Infant wide-field fundus photograph — 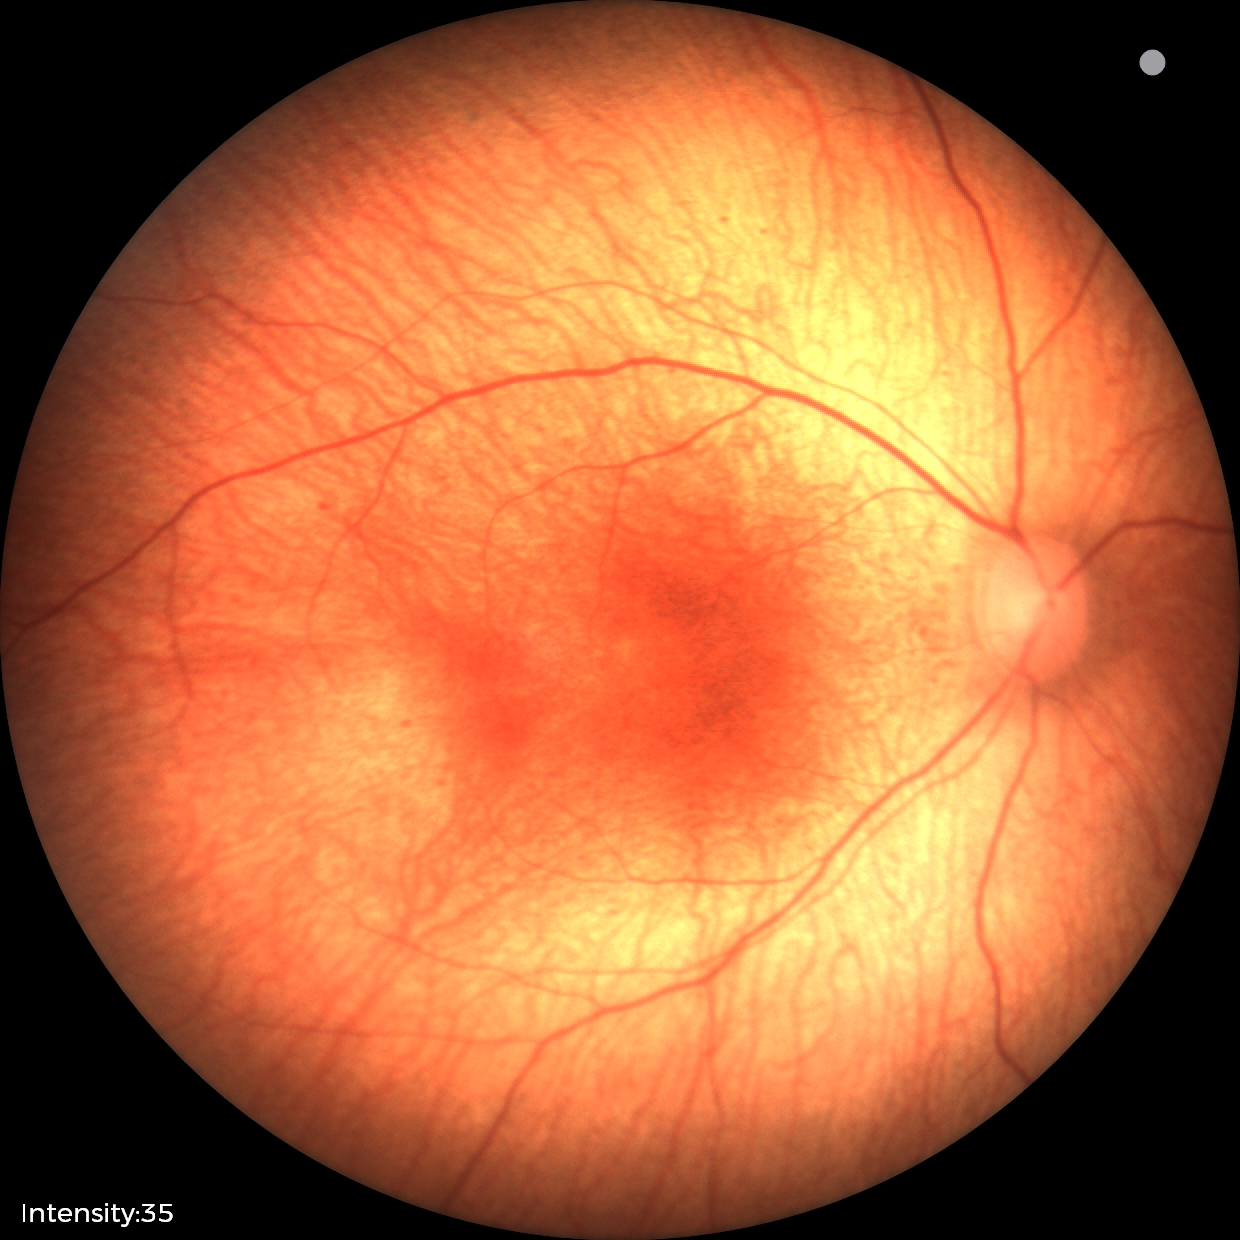
Examination with physiological retinal findings.